848x848px · graded on the modified Davis scale:
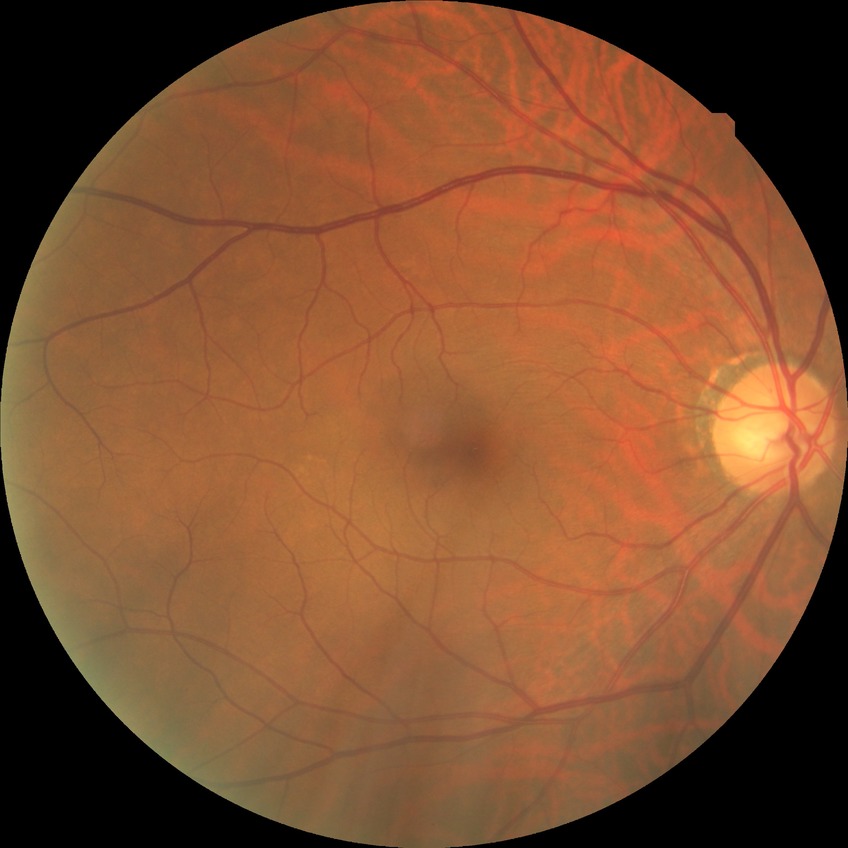 Annotations:
– diabetic retinopathy (DR) — NDR (no diabetic retinopathy)